Wide-field fundus photograph of an infant; 1440 x 1080 pixels; Natus RetCam Envision, 130° FOV — 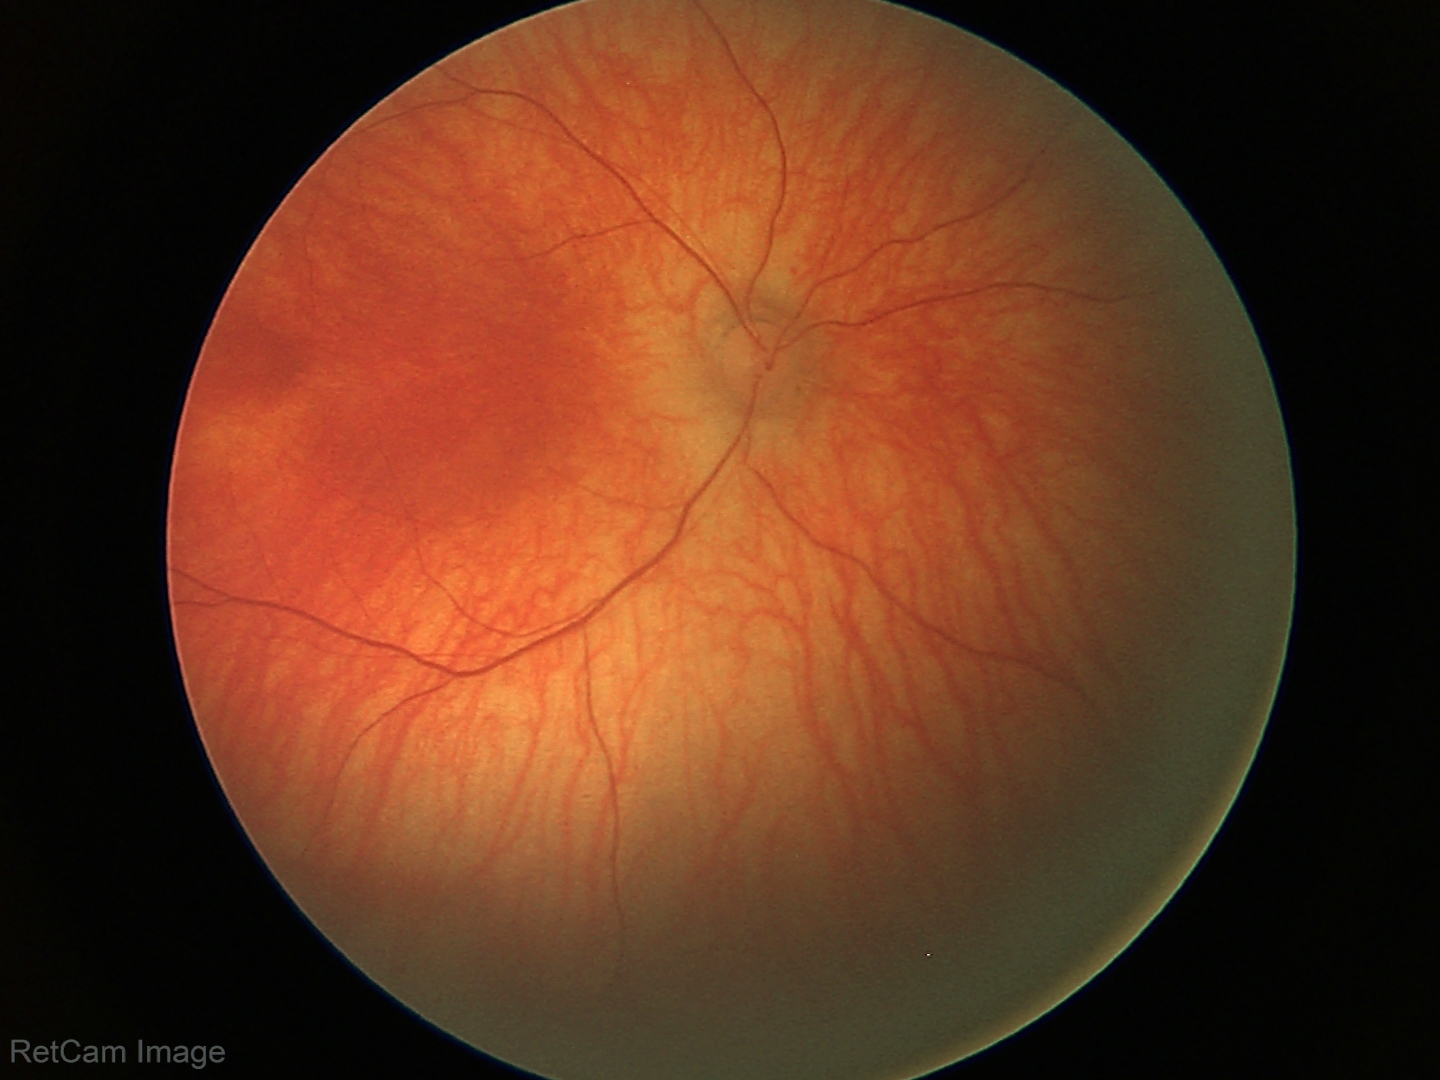 Normal screening examination.